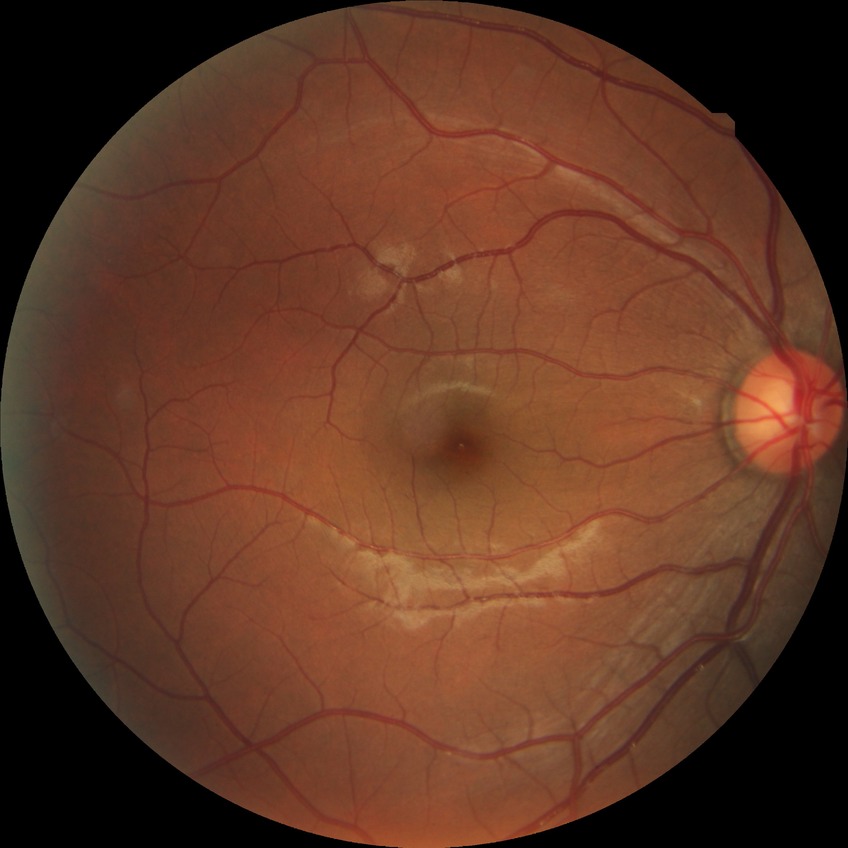
DR stage = NDR.